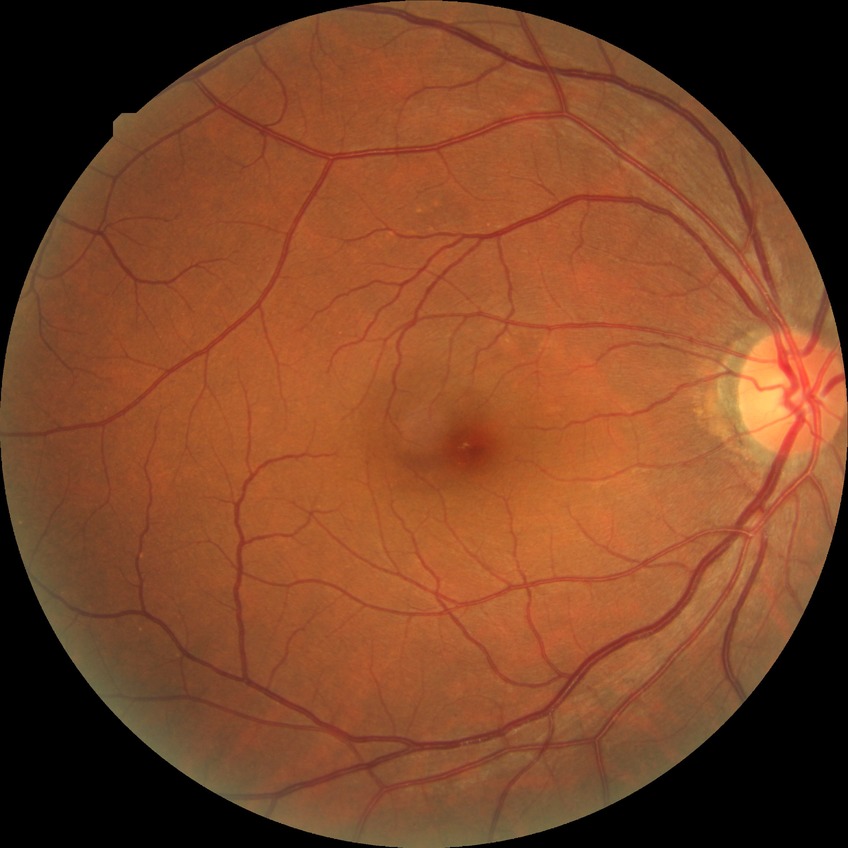

Modified Davis classification is no diabetic retinopathy.